Nonmydriatic fundus photograph · 848 by 848 pixels · 45° FOV.
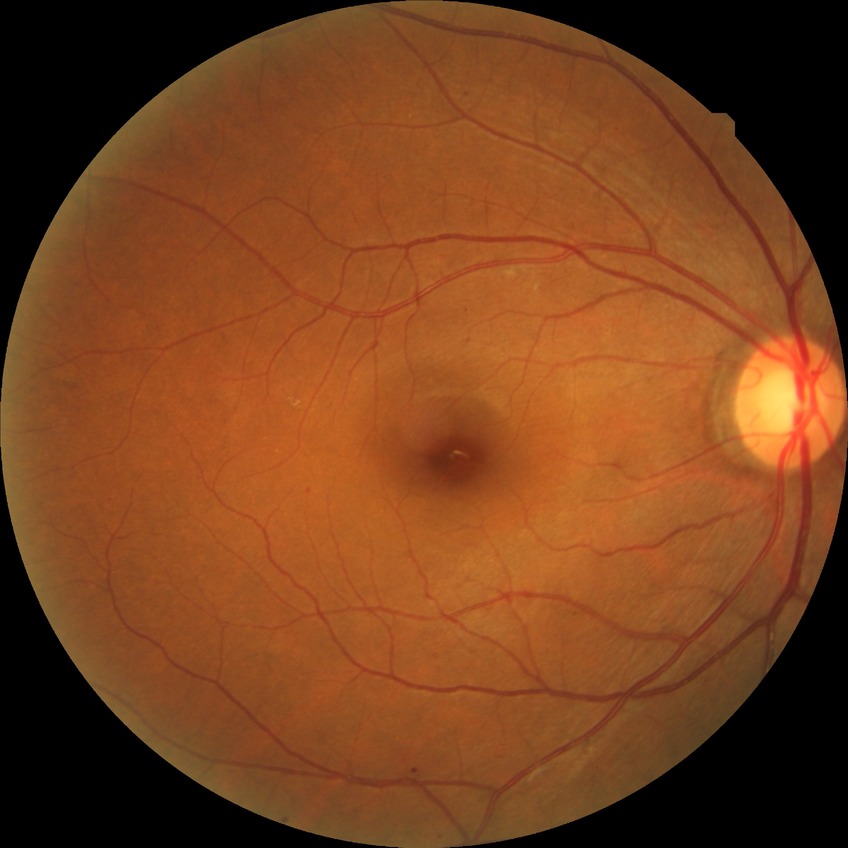

Diabetic retinopathy (DR) is simple diabetic retinopathy (SDR).